2212 by 1659 pixels:
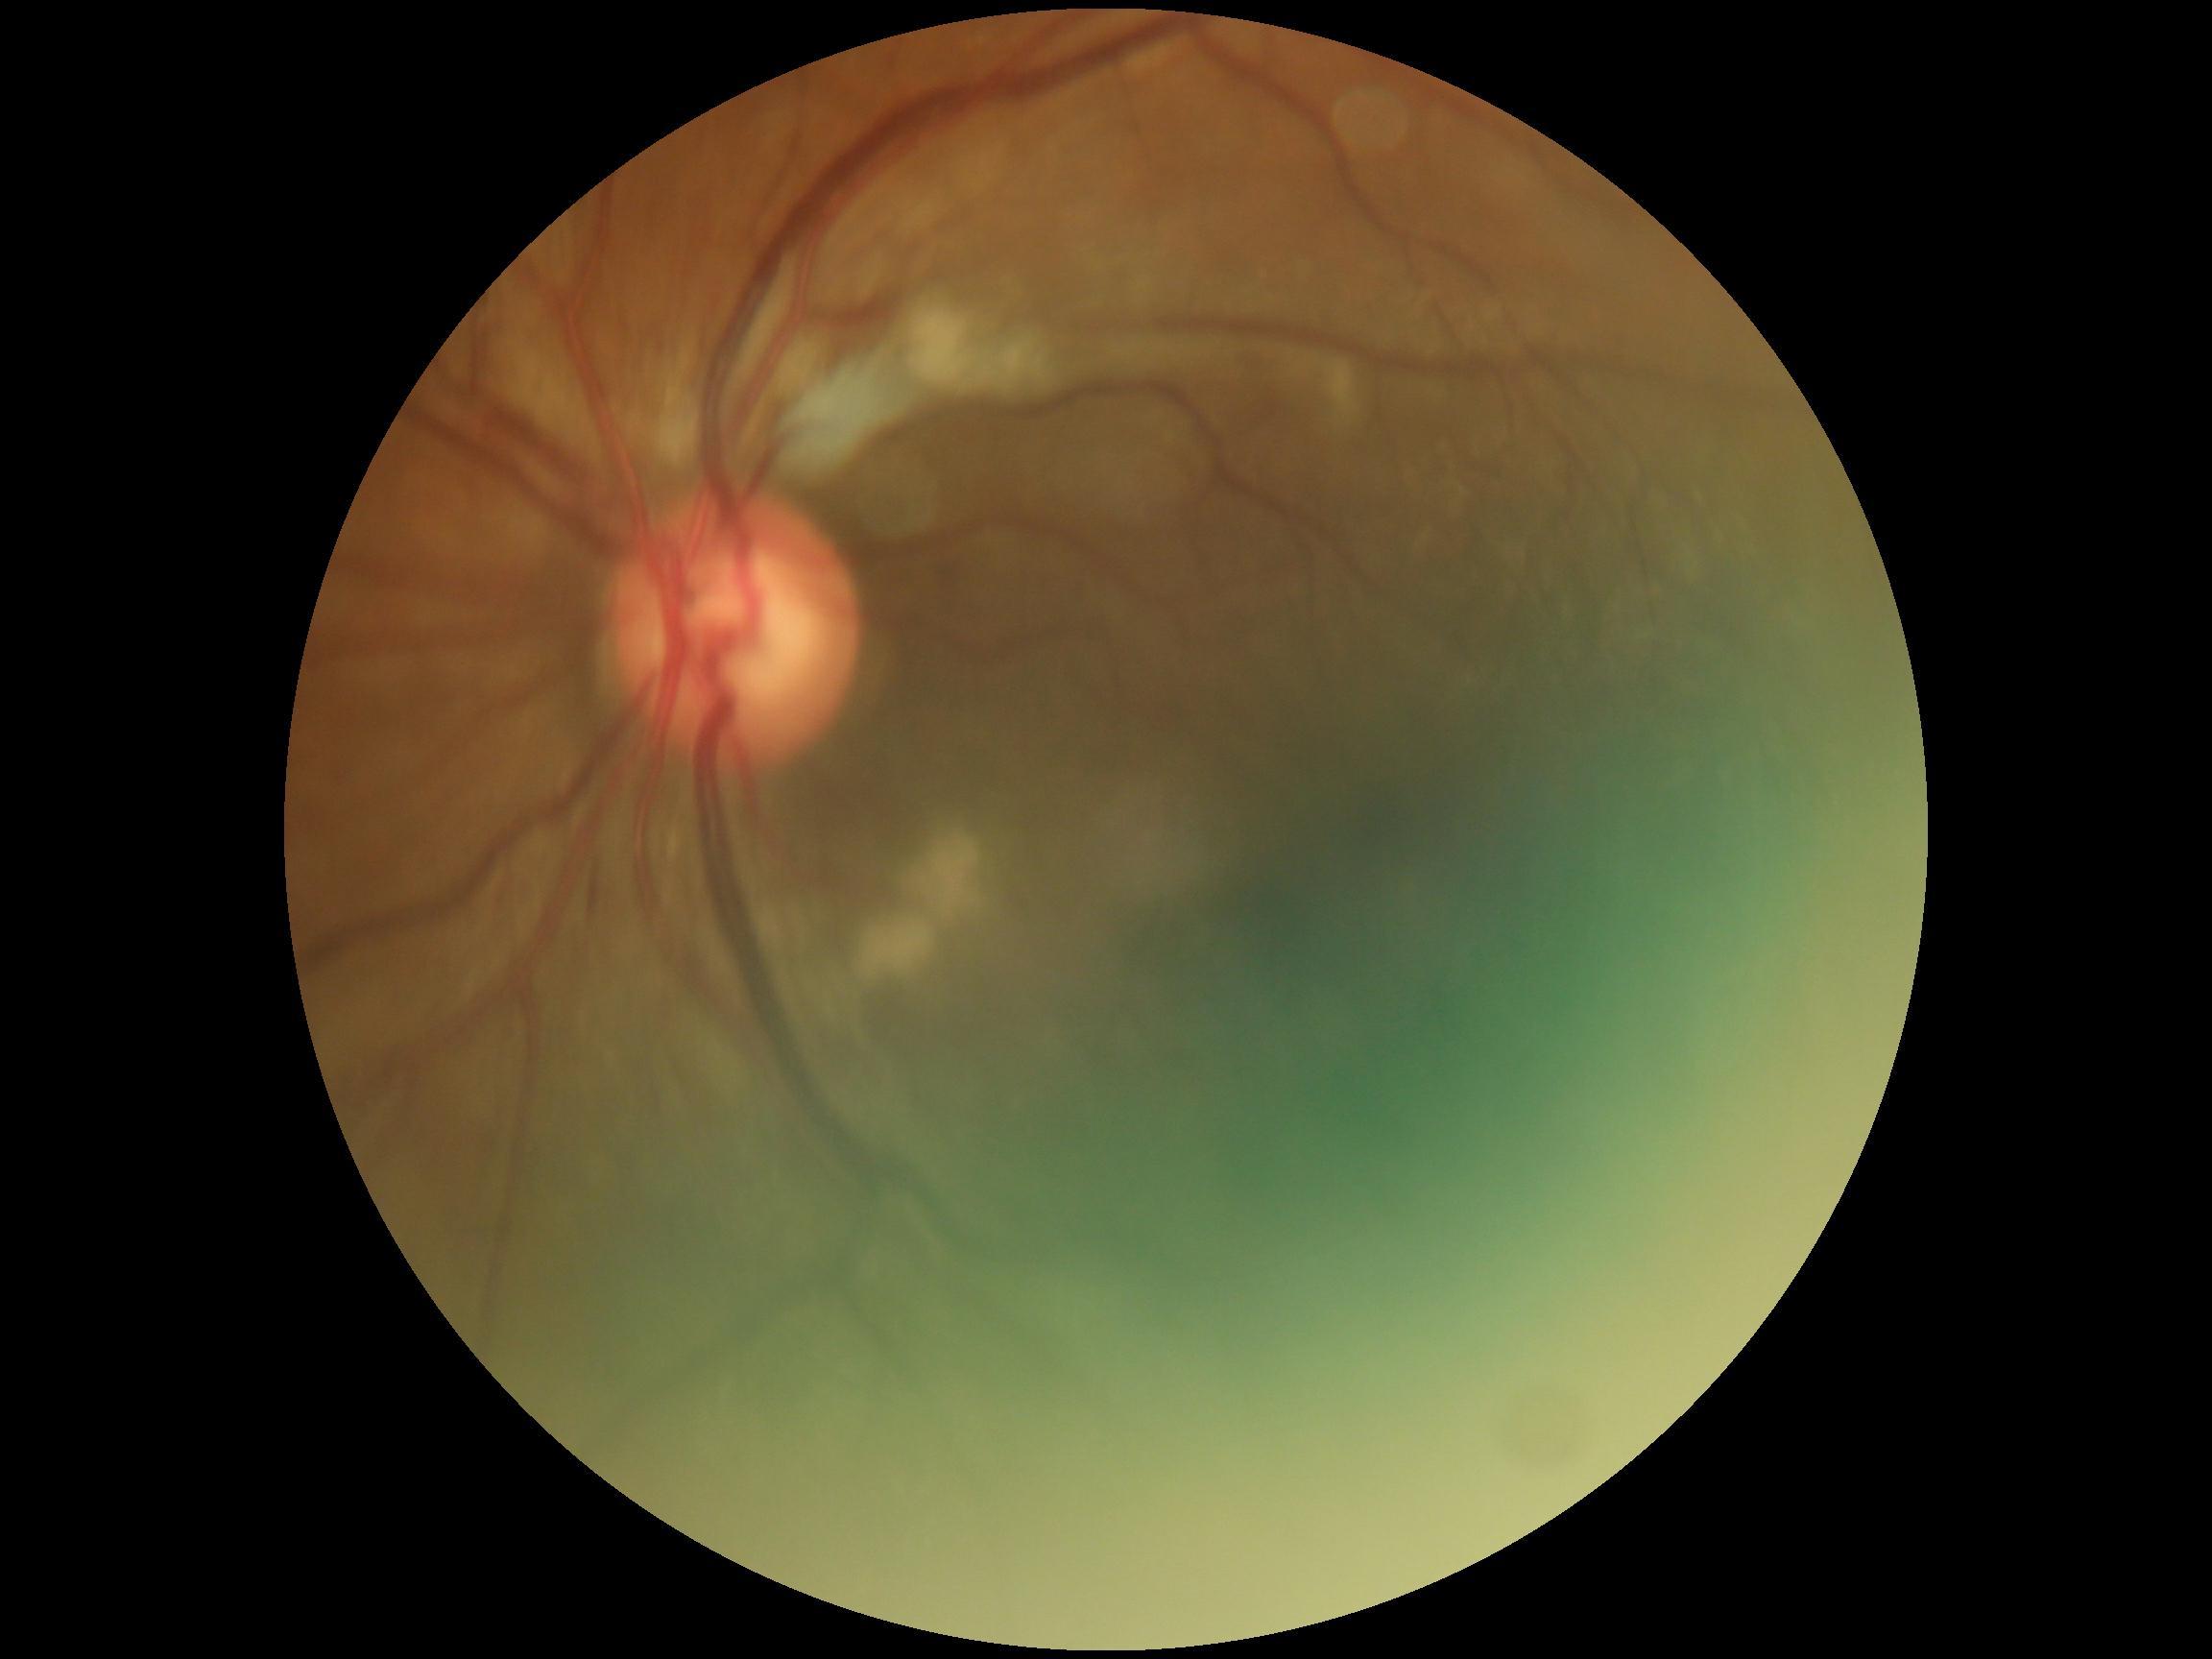 Diabetic retinopathy severity is grade 2 (moderate NPDR). DR class: non-proliferative diabetic retinopathy.